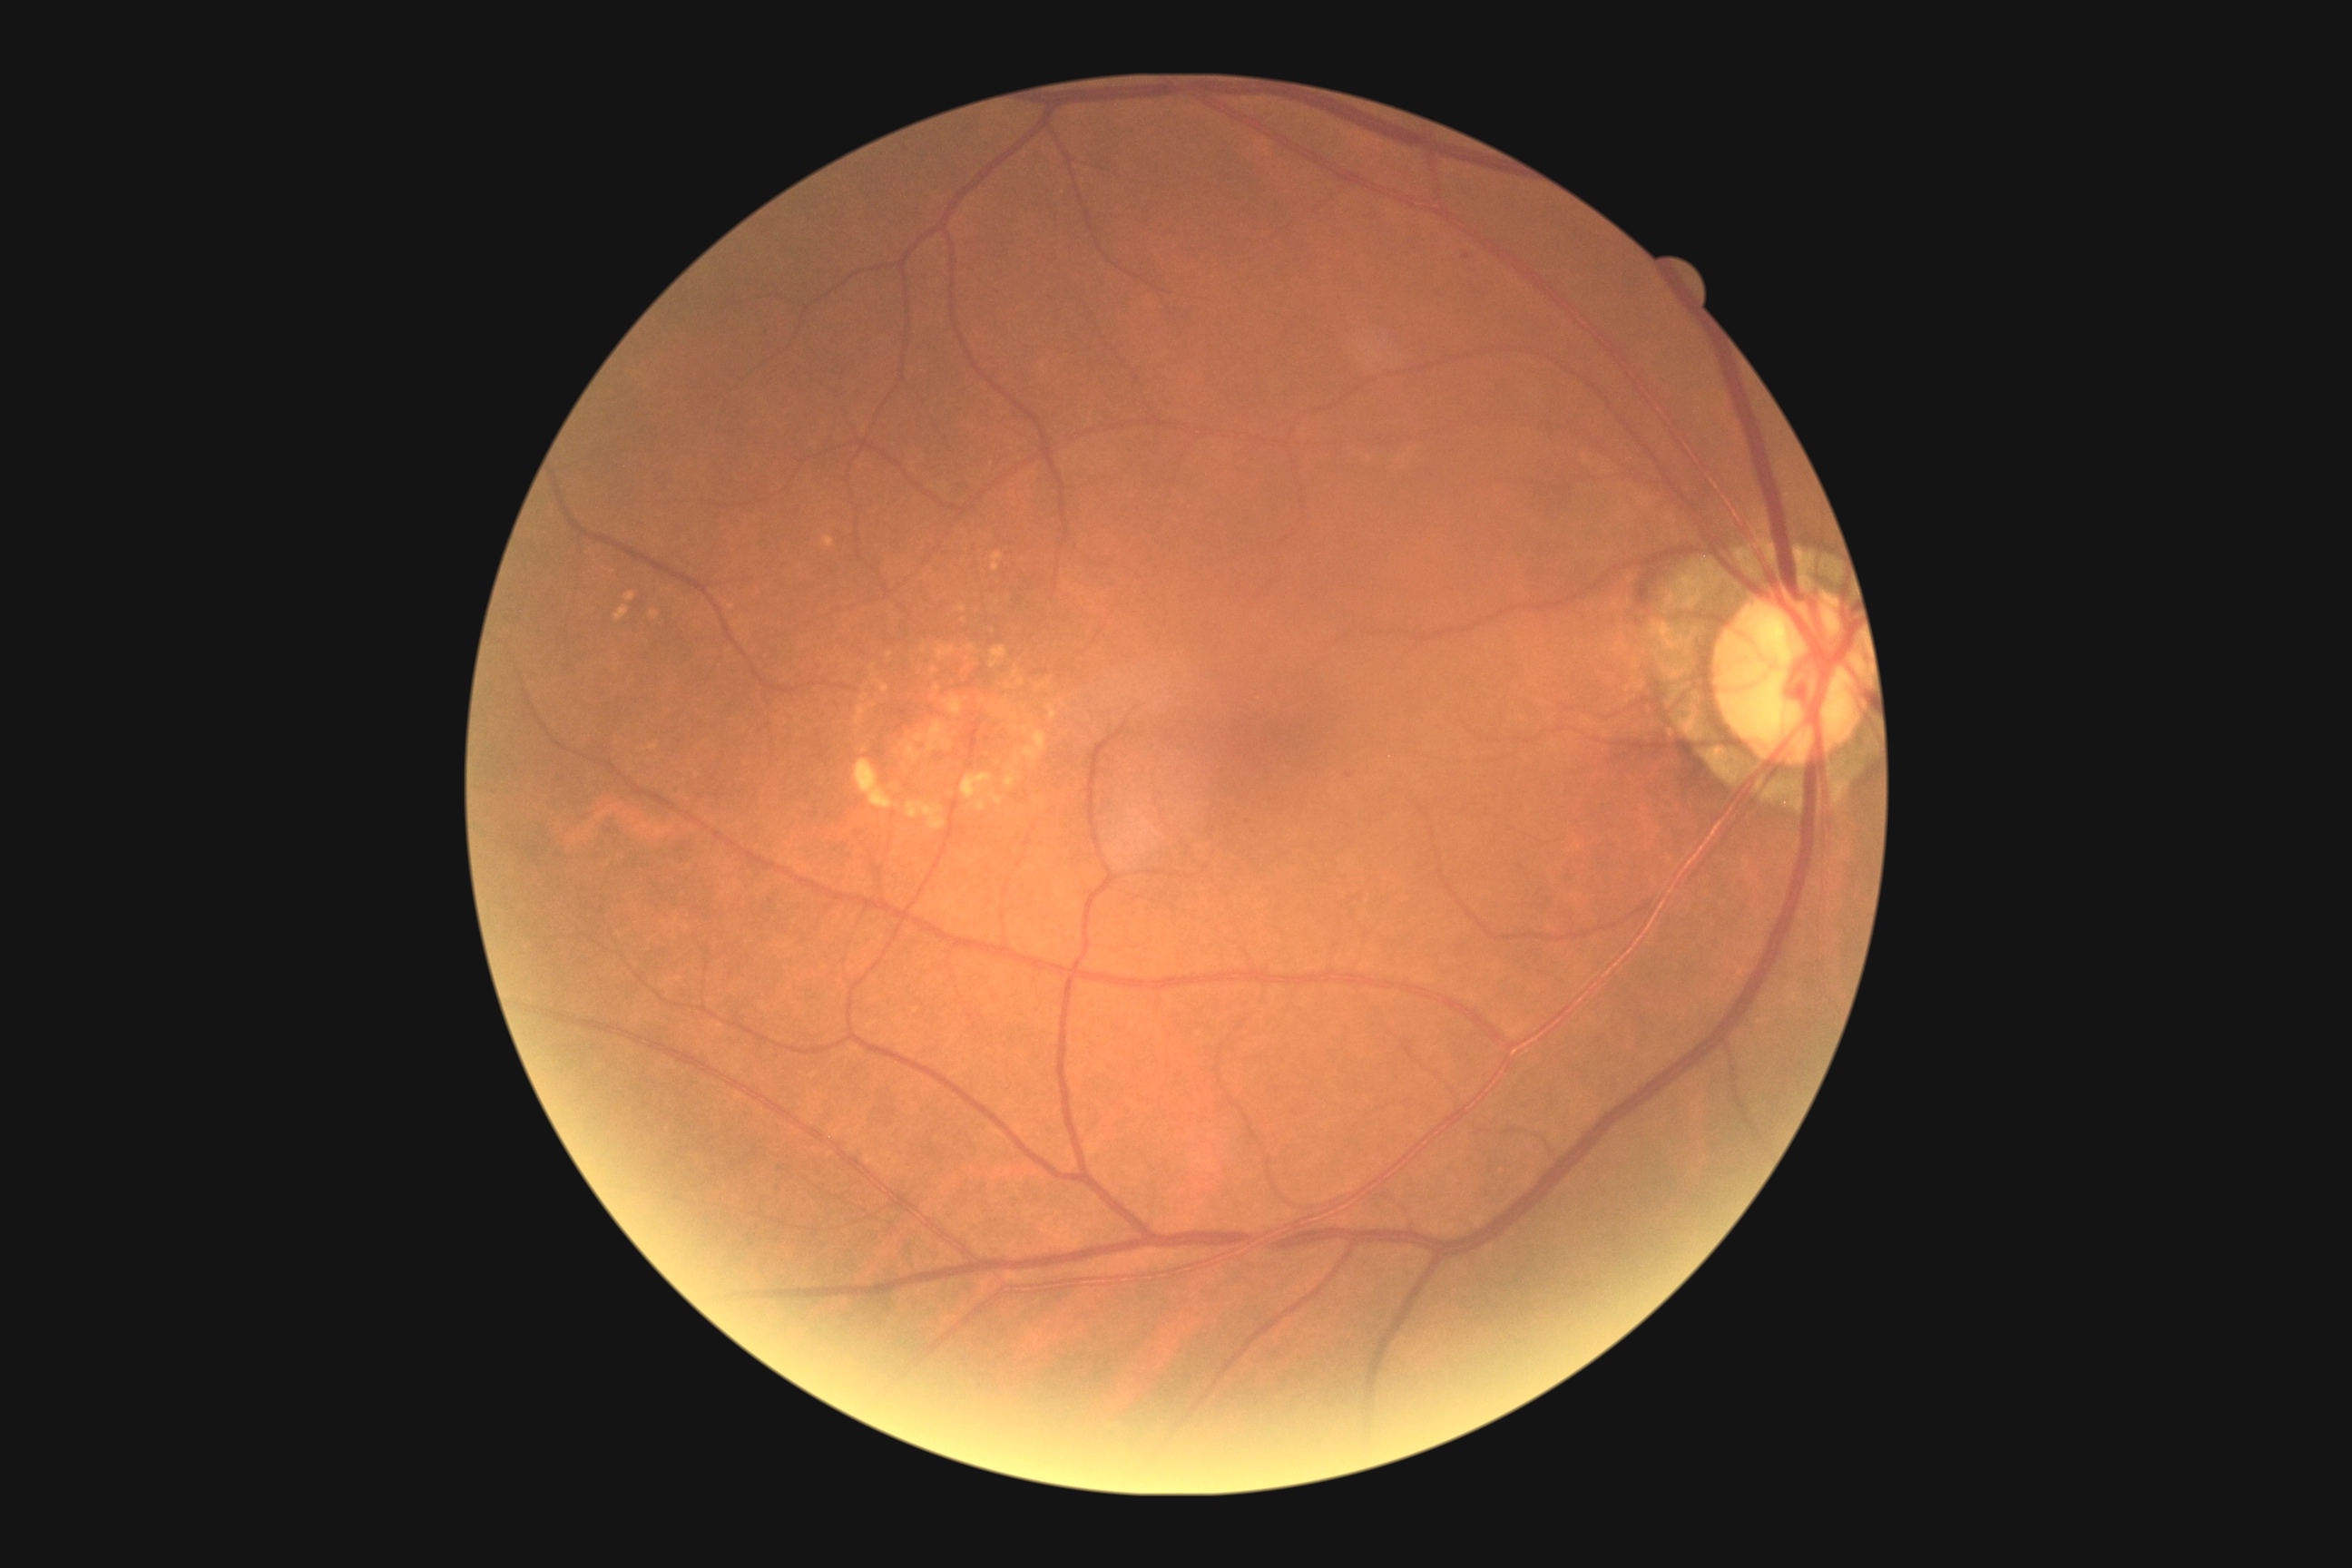 DR severity is grade 1 (mild NPDR); non-proliferative diabetic retinopathy.
No EXs identified.
MAs include those at bbox(1346, 772, 1355, 778) | bbox(750, 1244, 758, 1251).
Additional small MAs near <point>1466, 257</point>.
No SEs identified.
No HEs identified.